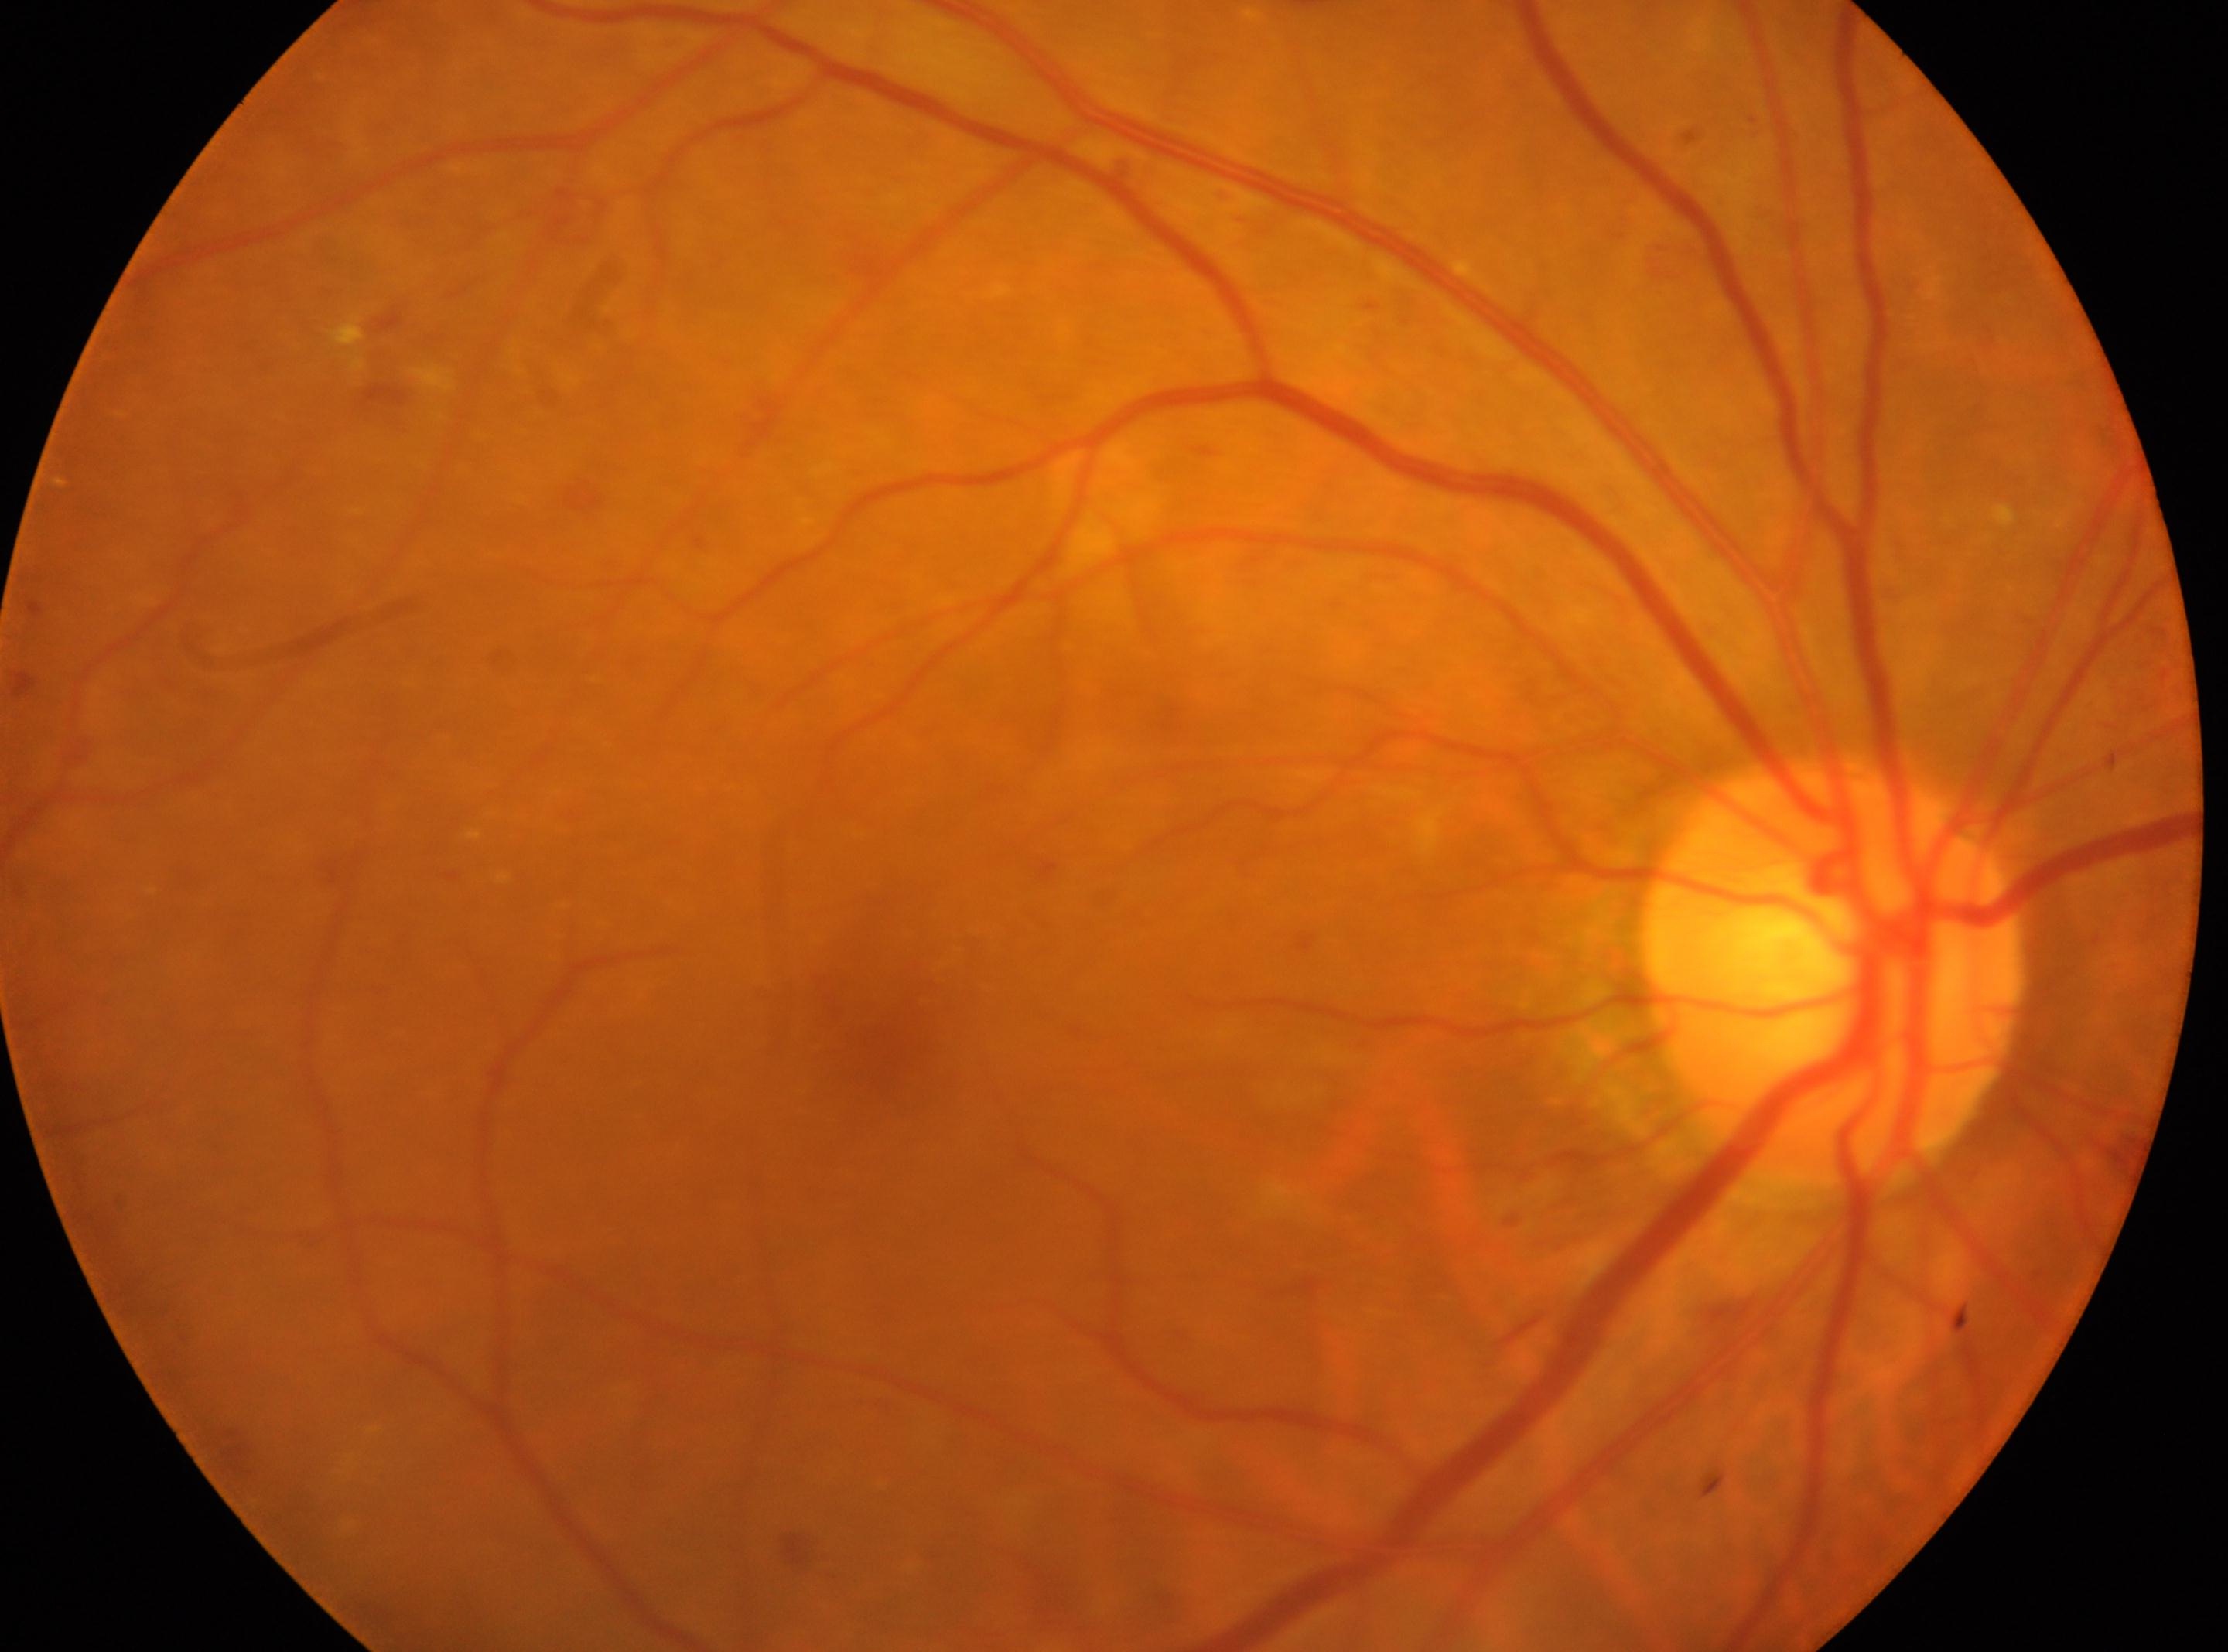
retinopathy grade: moderate NPDR (2) — more than just microaneurysms but less than severe NPDR; OD; ONH: (x=1830, y=968); fovea: (x=883, y=1036).